100° field of view (Phoenix ICON) · 1240 x 1240 pixels · wide-field fundus image from infant ROP screening:
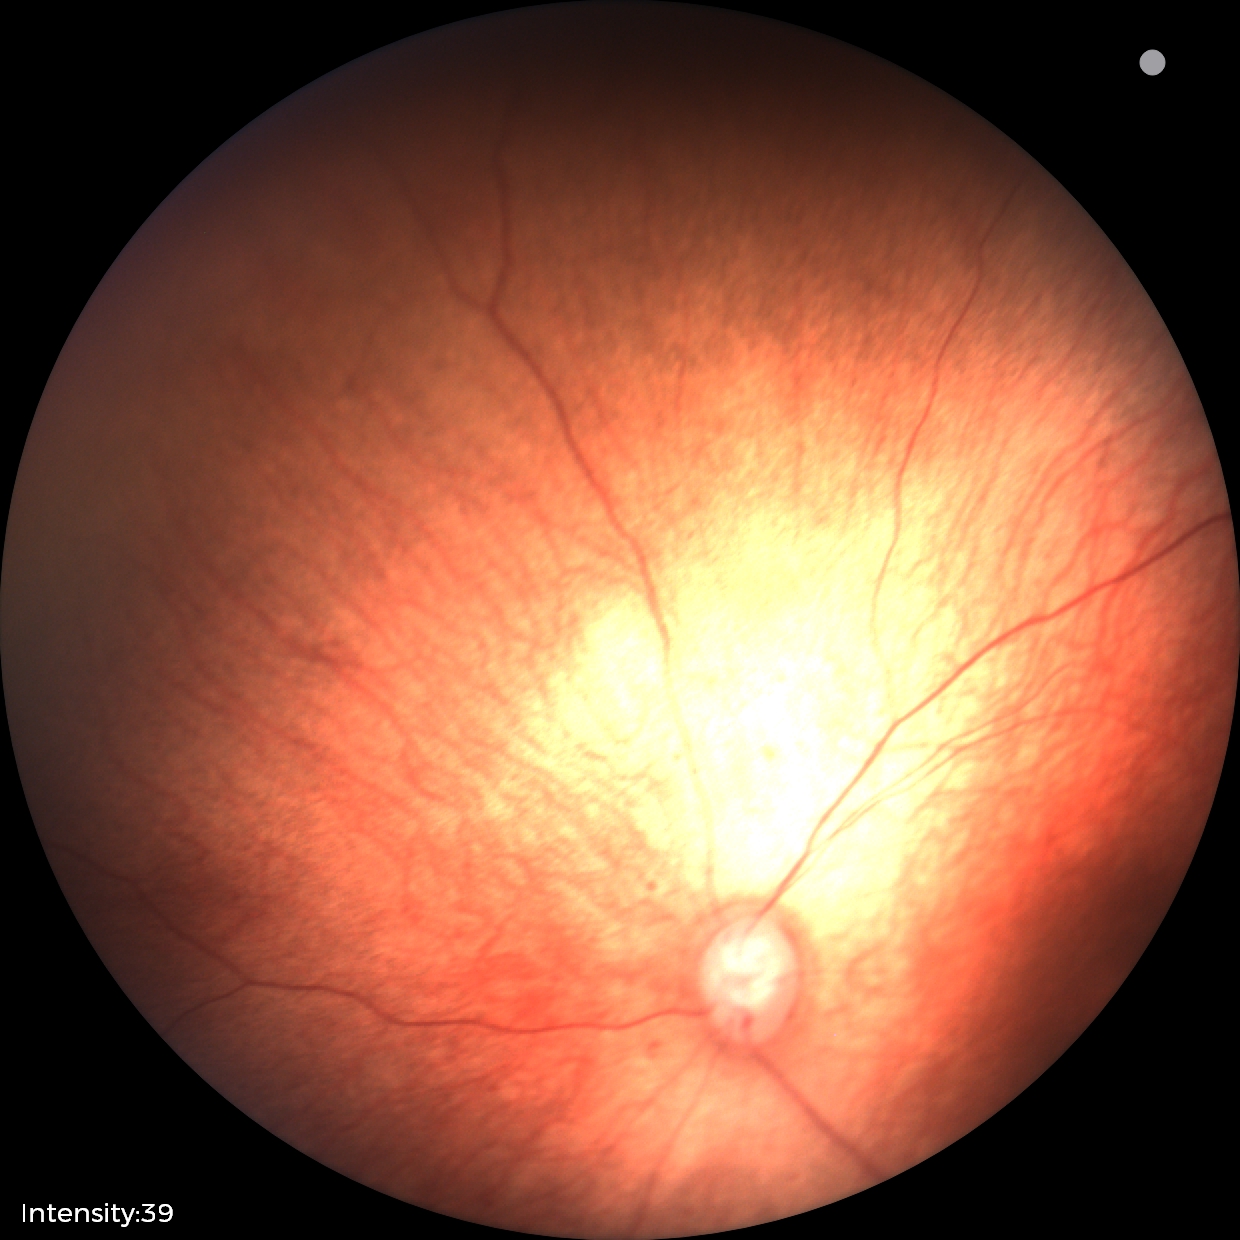 Normal screening examination.